848 x 848 pixels · nonmydriatic fundus photograph
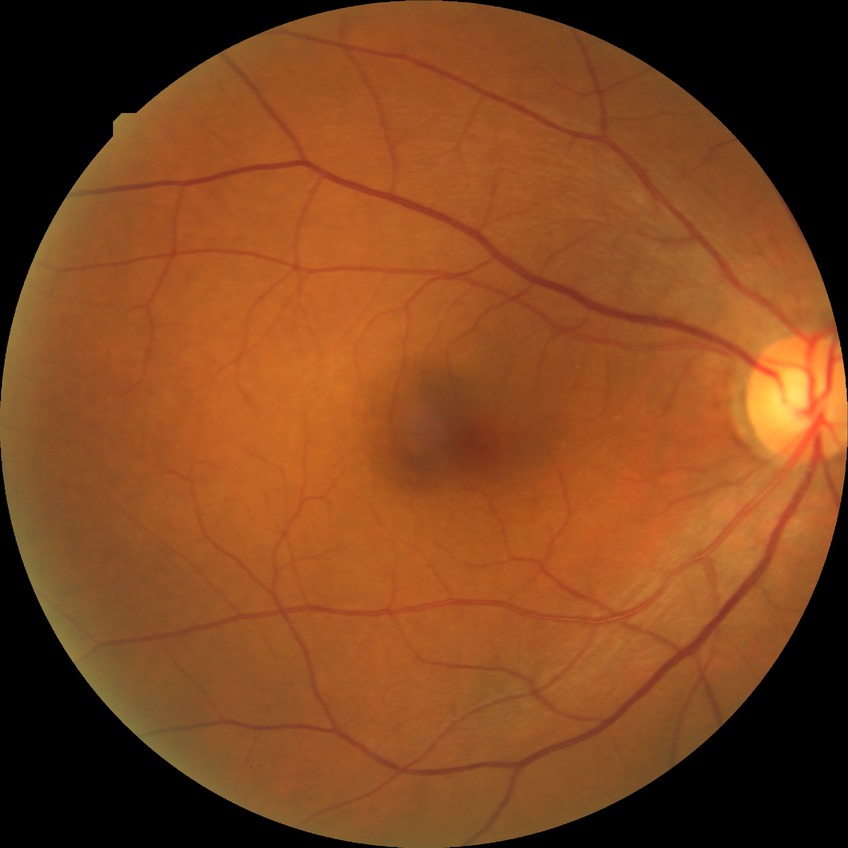

diabetic retinopathy stage = no diabetic retinopathy.